Wide-field retinal mosaic image.
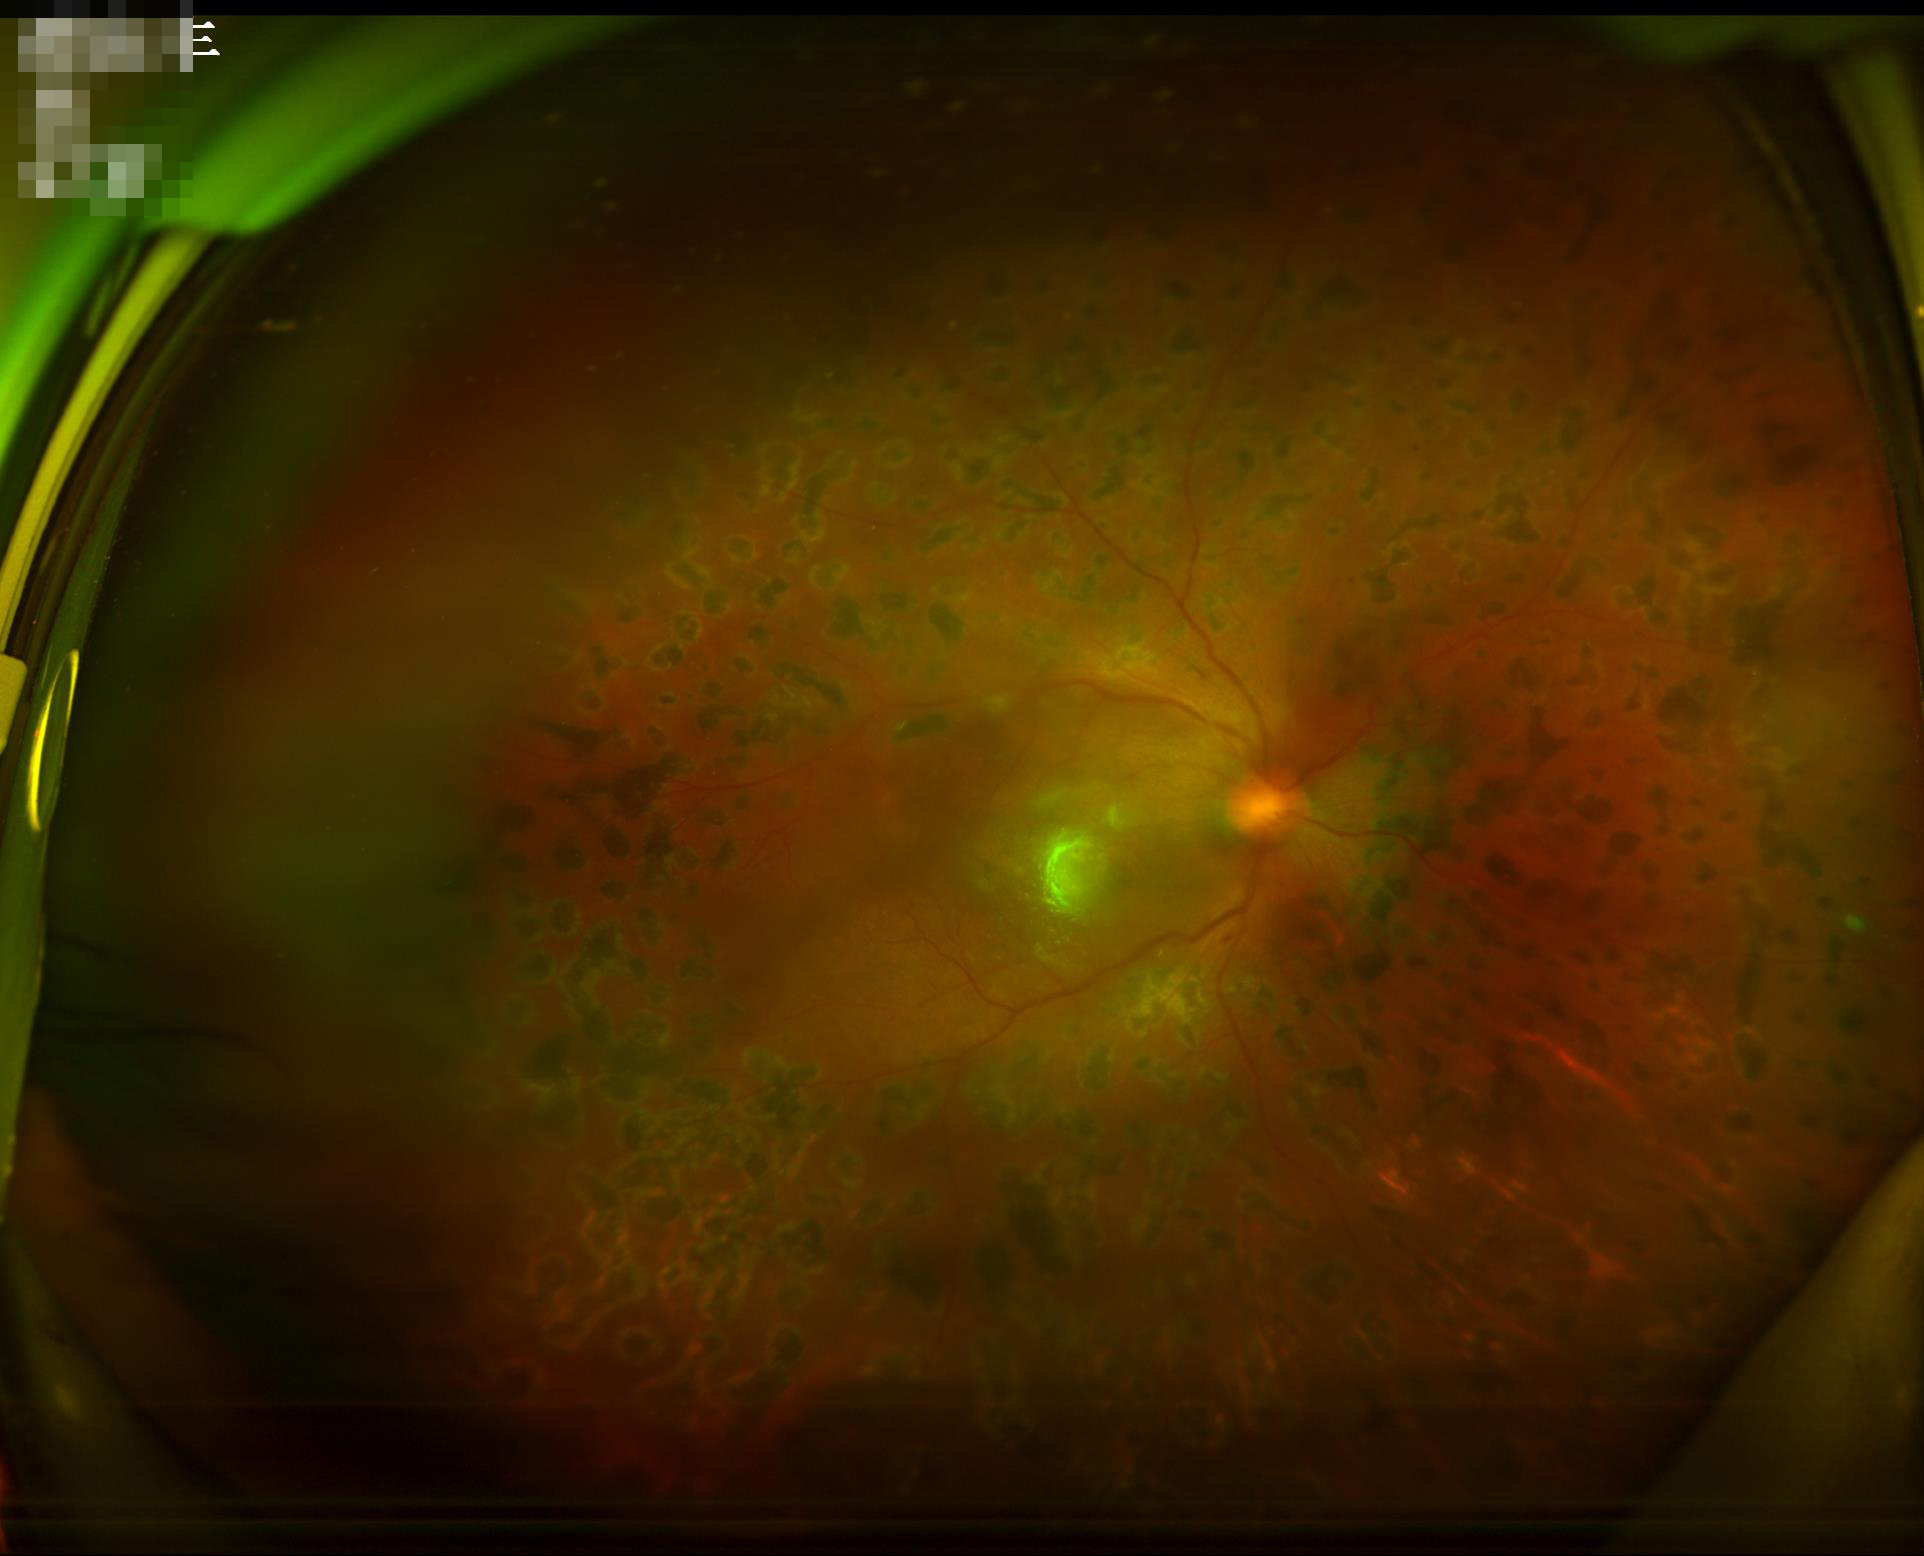

Illumination and color are suboptimal. Overall image quality is poor. Adequate contrast for distinguishing structures. Noticeable blur in the optic disc, vessels, or background.